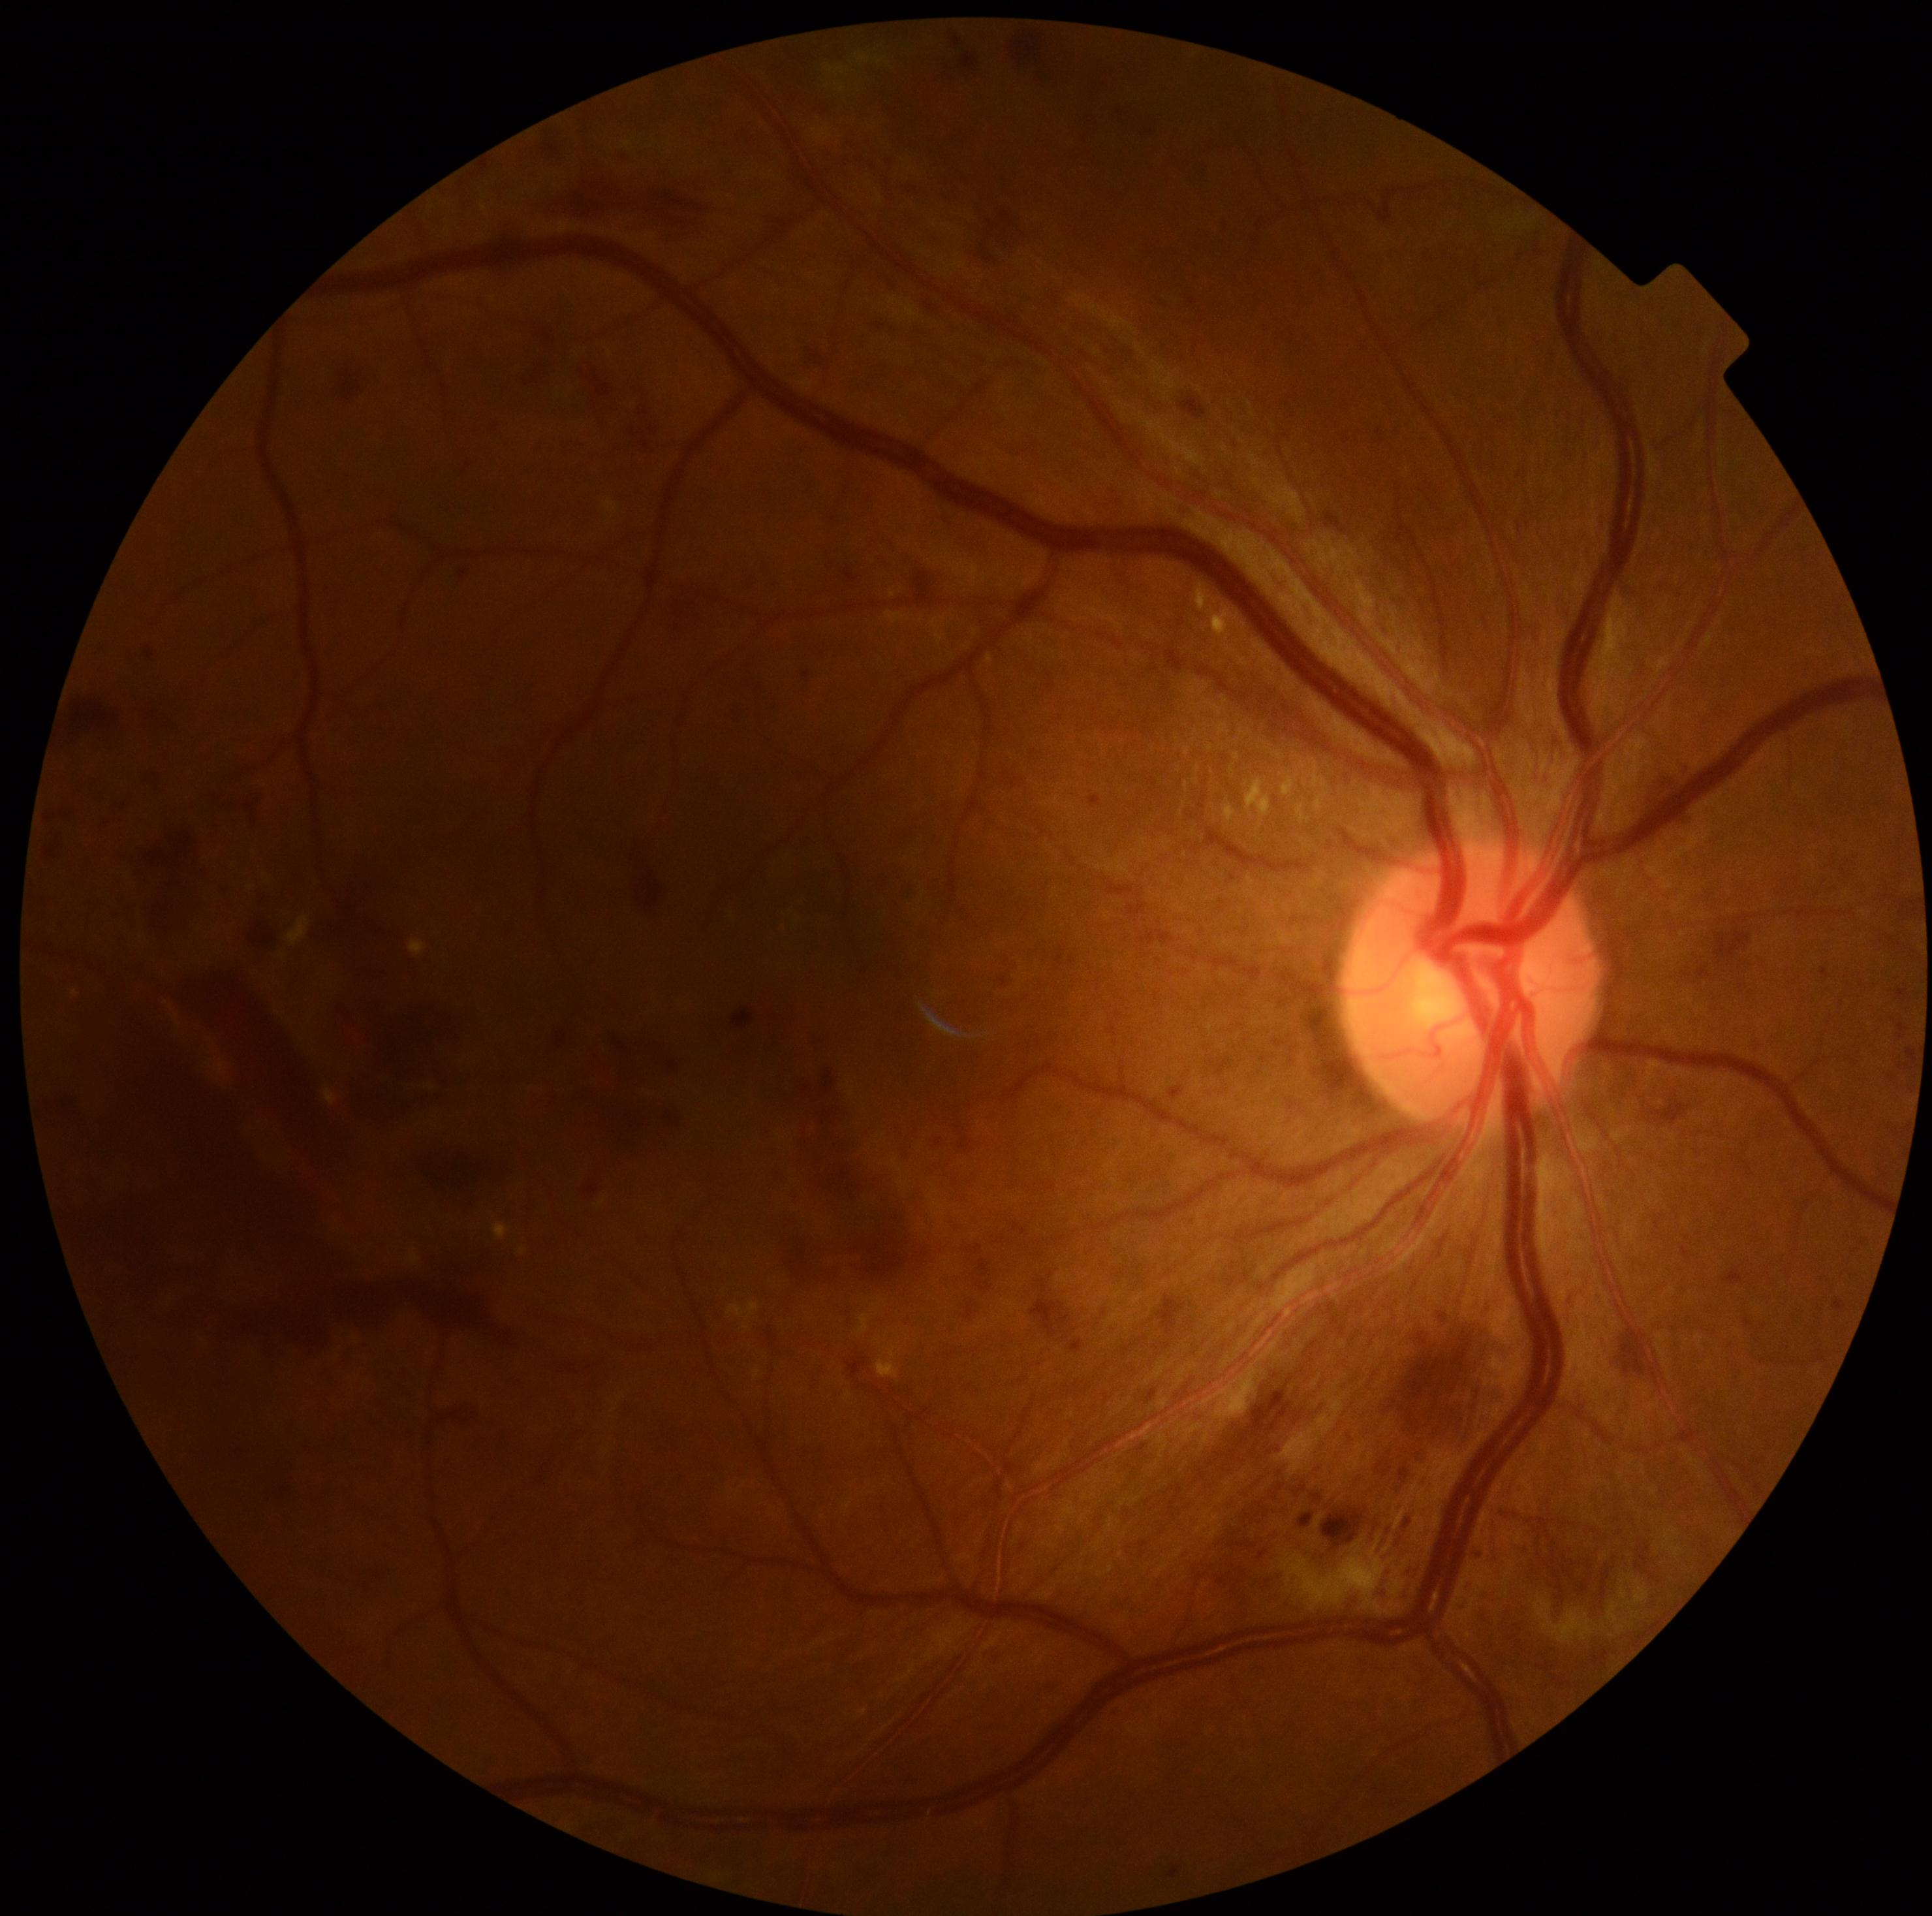
DR grade: 4/4, DR class: proliferative diabetic retinopathy.